Acquired with a NIDEK AFC-230. 848x848px
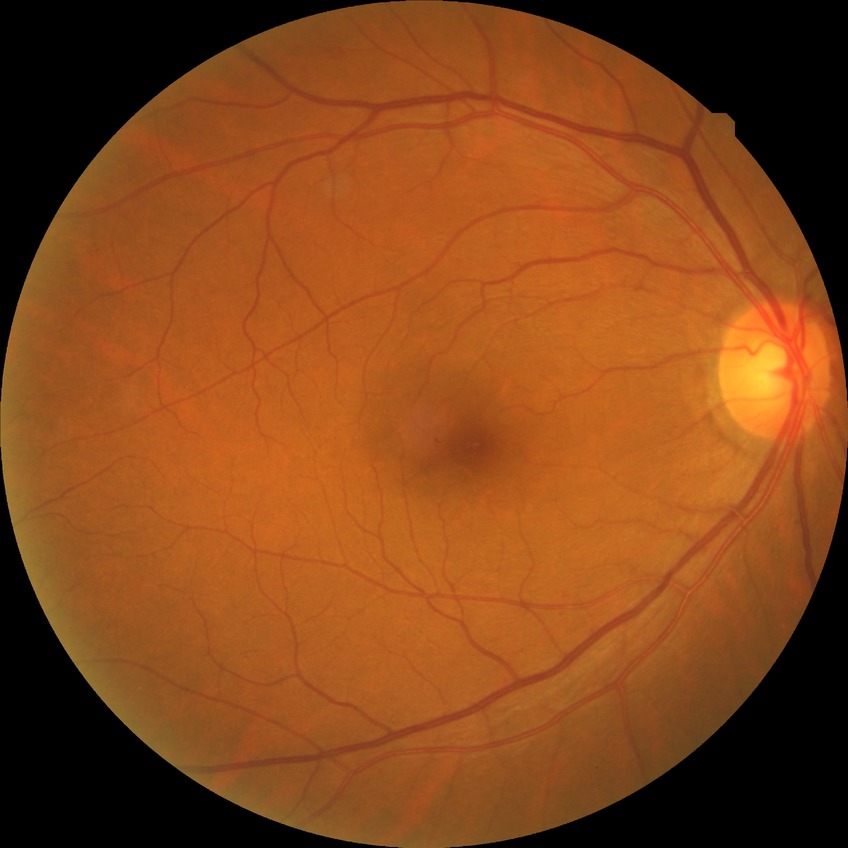
Modified Davis grade is SDR.